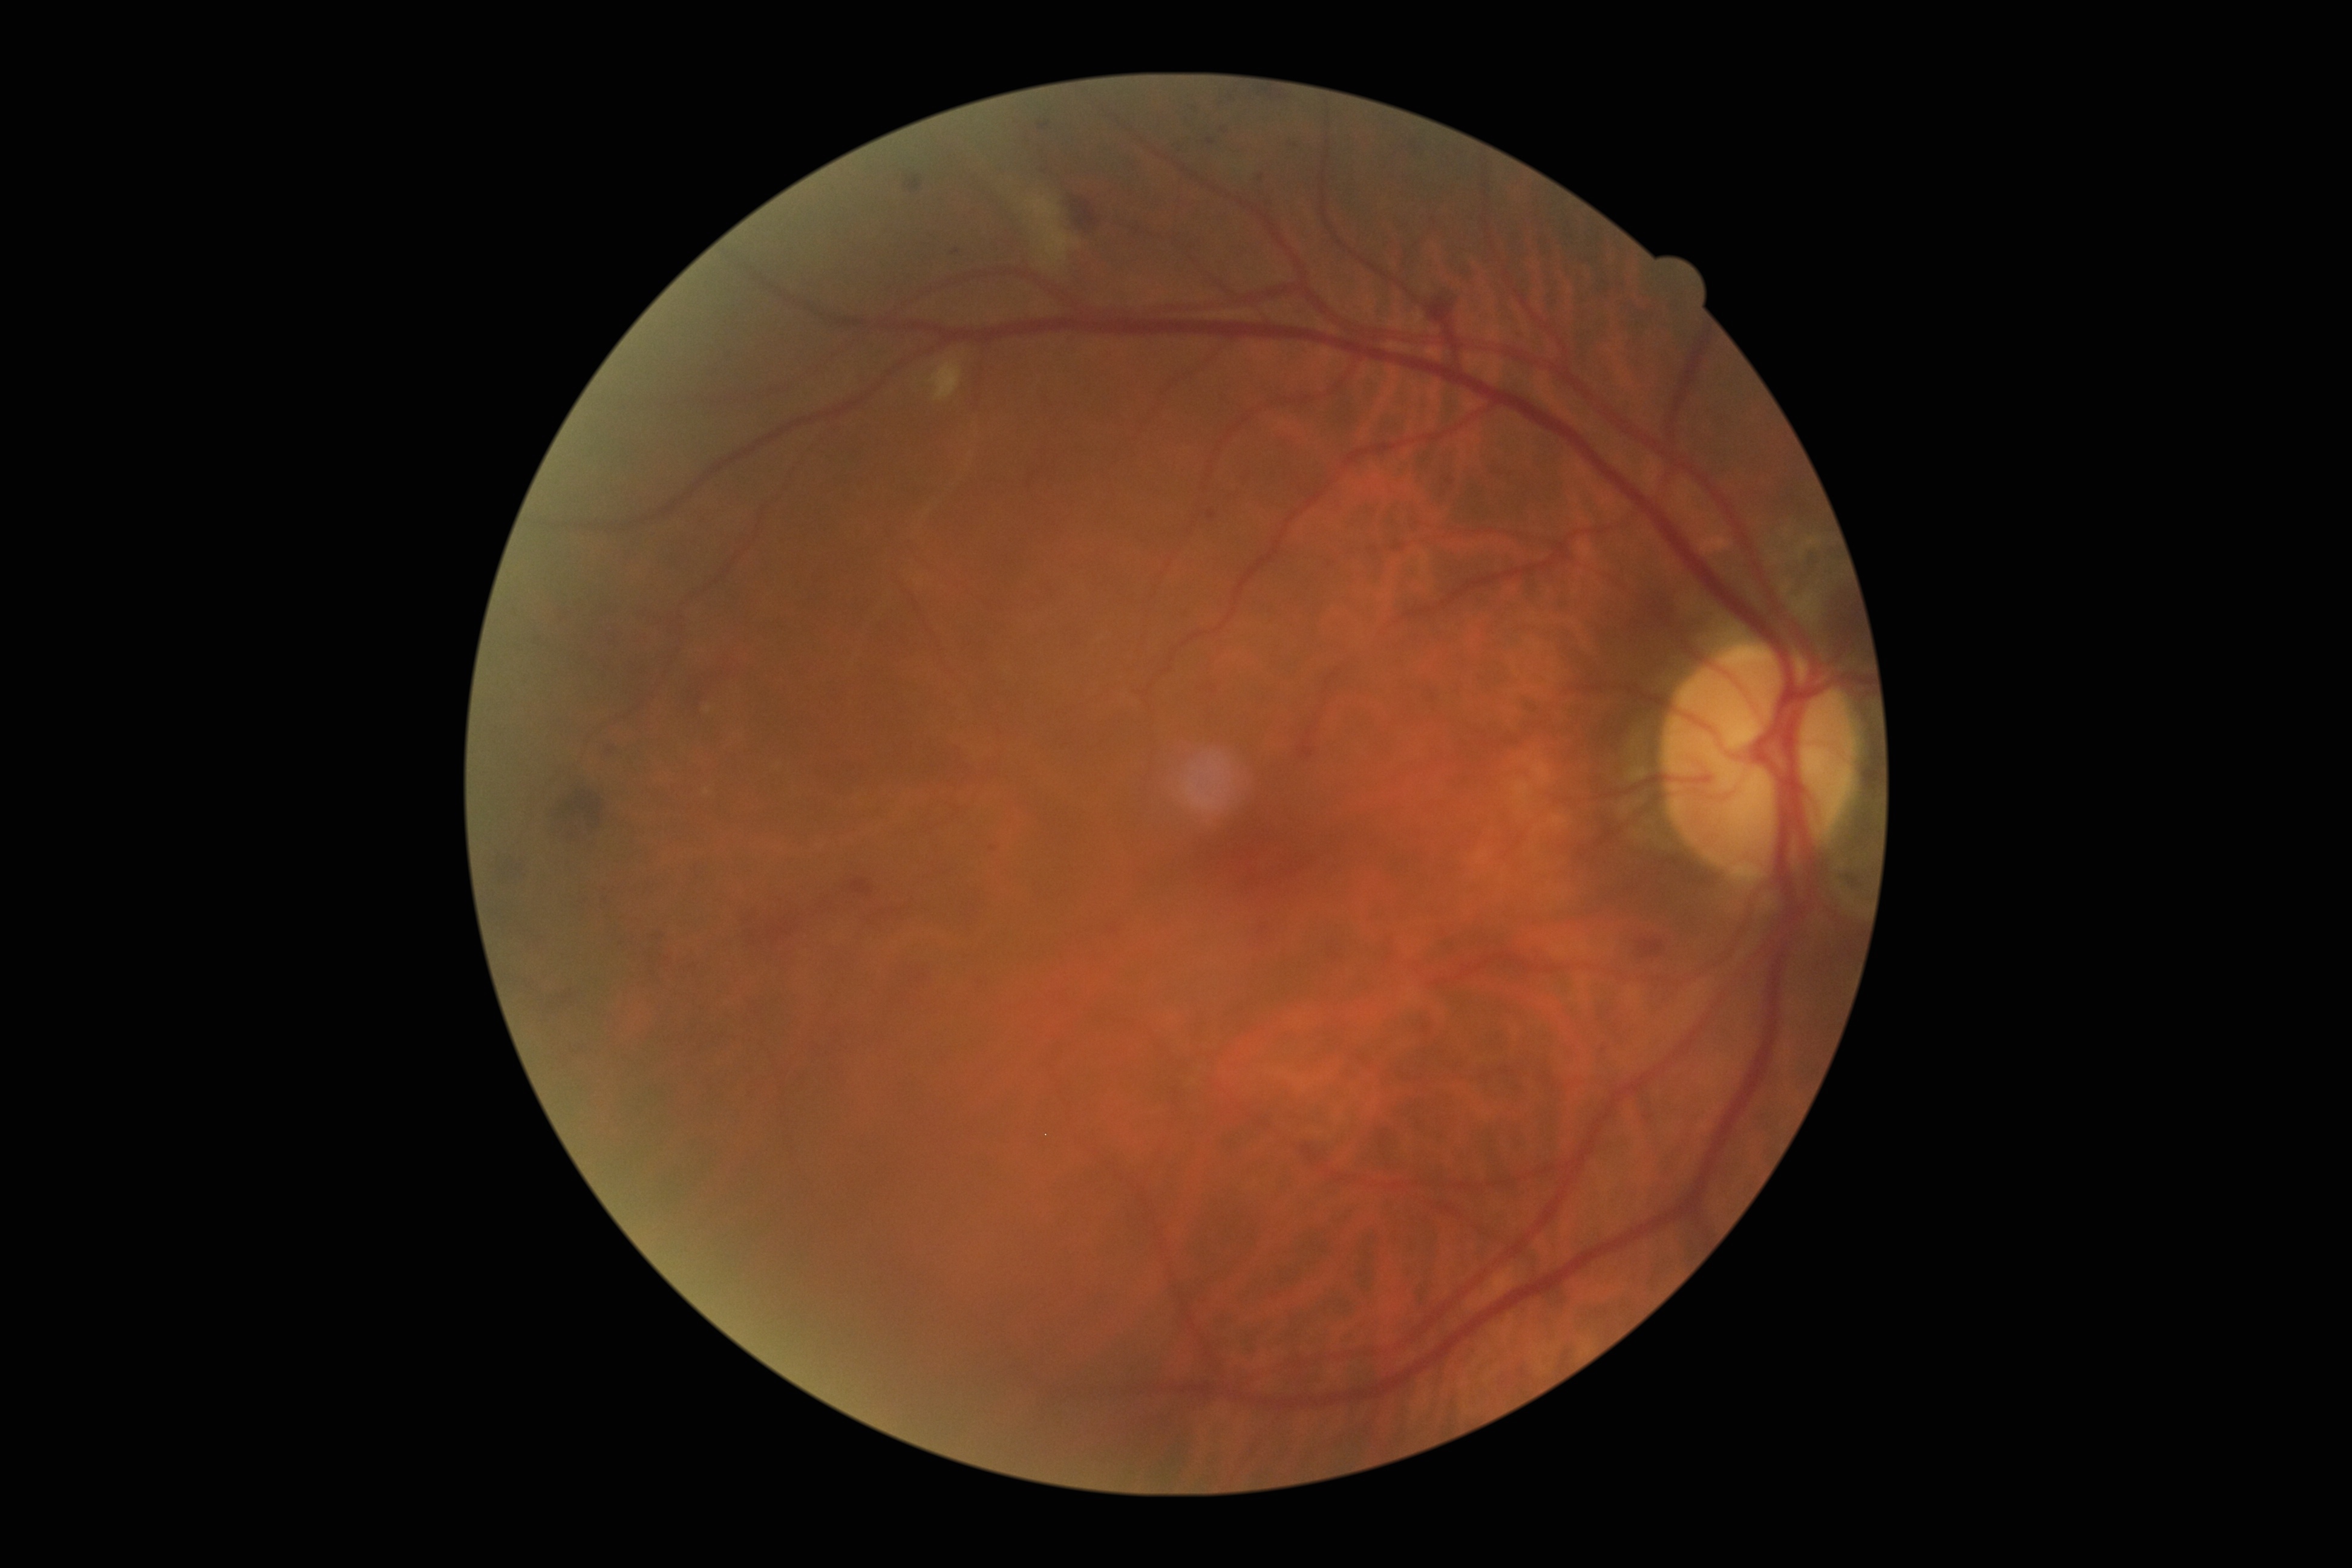
{"dr_grade": "grade 2 (moderate NPDR)"}